Fundus photo:
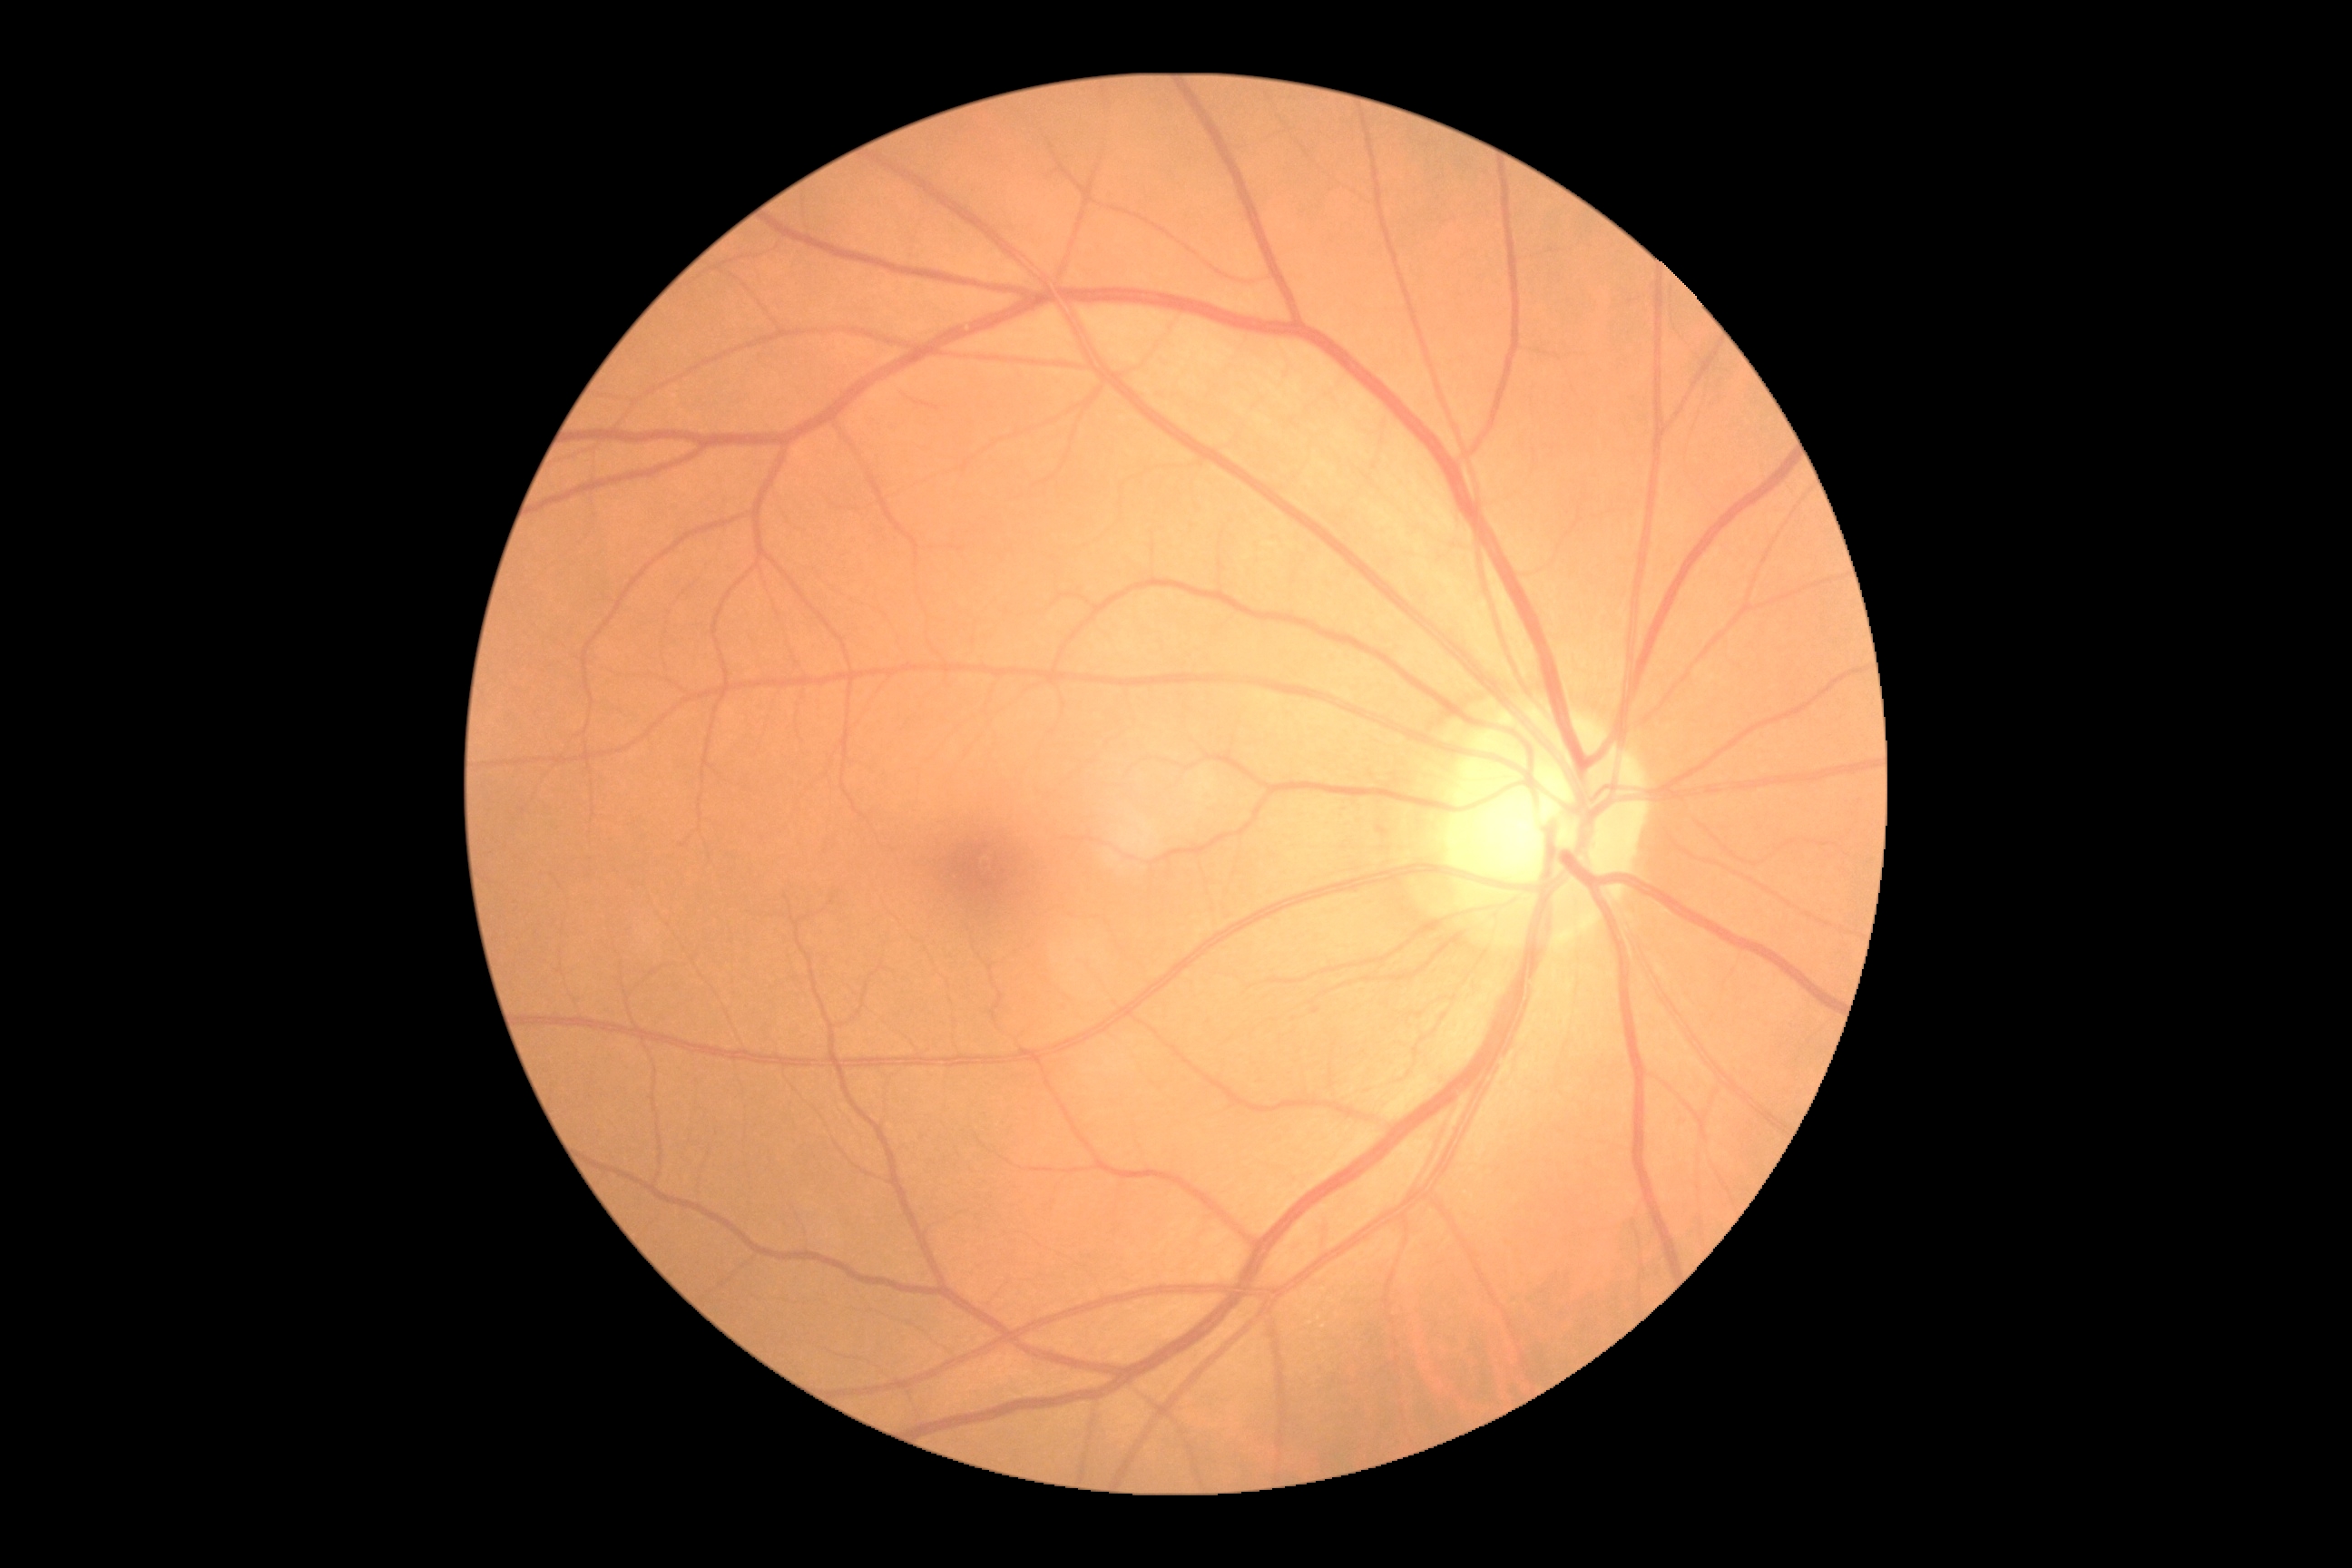 Retinopathy grade: 0/4.